CFP: 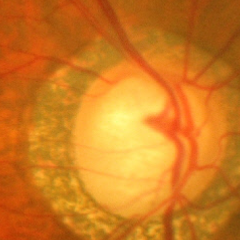
Findings consistent with glaucoma. The image shows advanced-stage glaucoma.